Color fundus image:
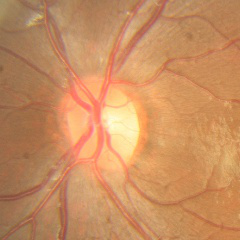

The image shows no signs of glaucoma.